Captured on a Nidek AFC-330 fundus camera — 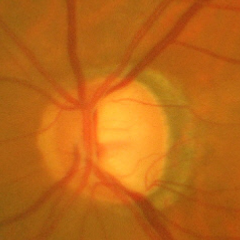

Diagnosis: advanced-stage glaucoma.